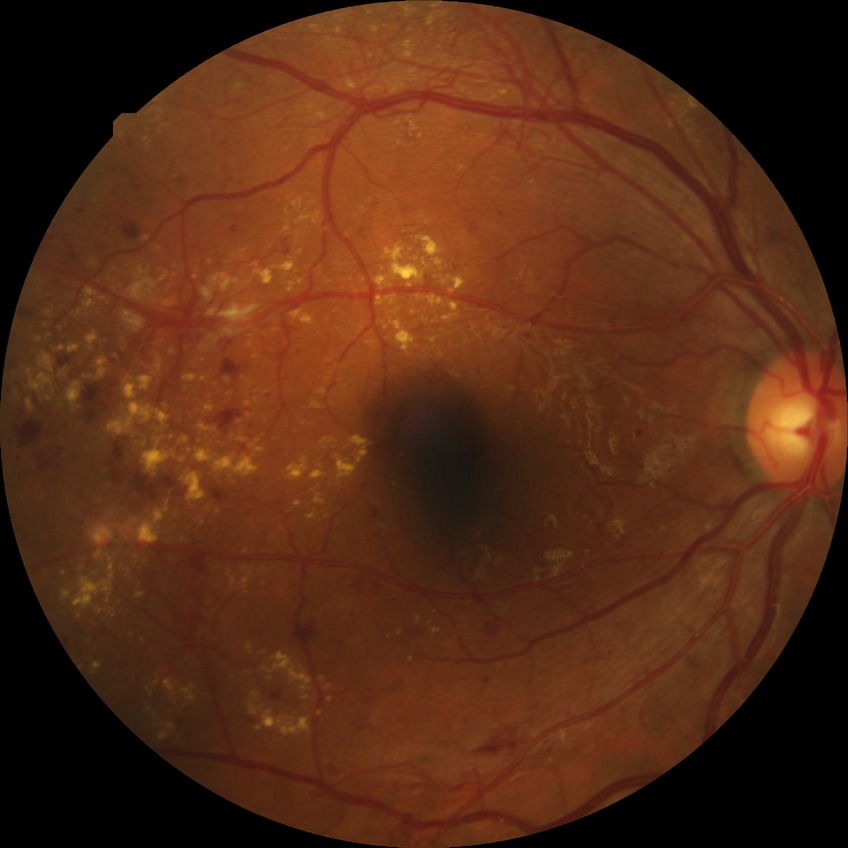
diabetic retinopathy (DR): PDR (proliferative diabetic retinopathy).